640 by 480 pixels · captured with the Clarity RetCam 3 (130° field of view) · wide-field fundus photograph of an infant — 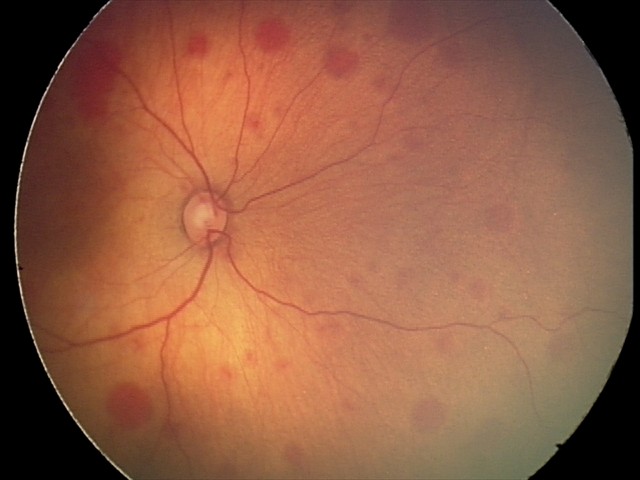

Q: What is the screening diagnosis?
A: retinal hemorrhages